45° FOV
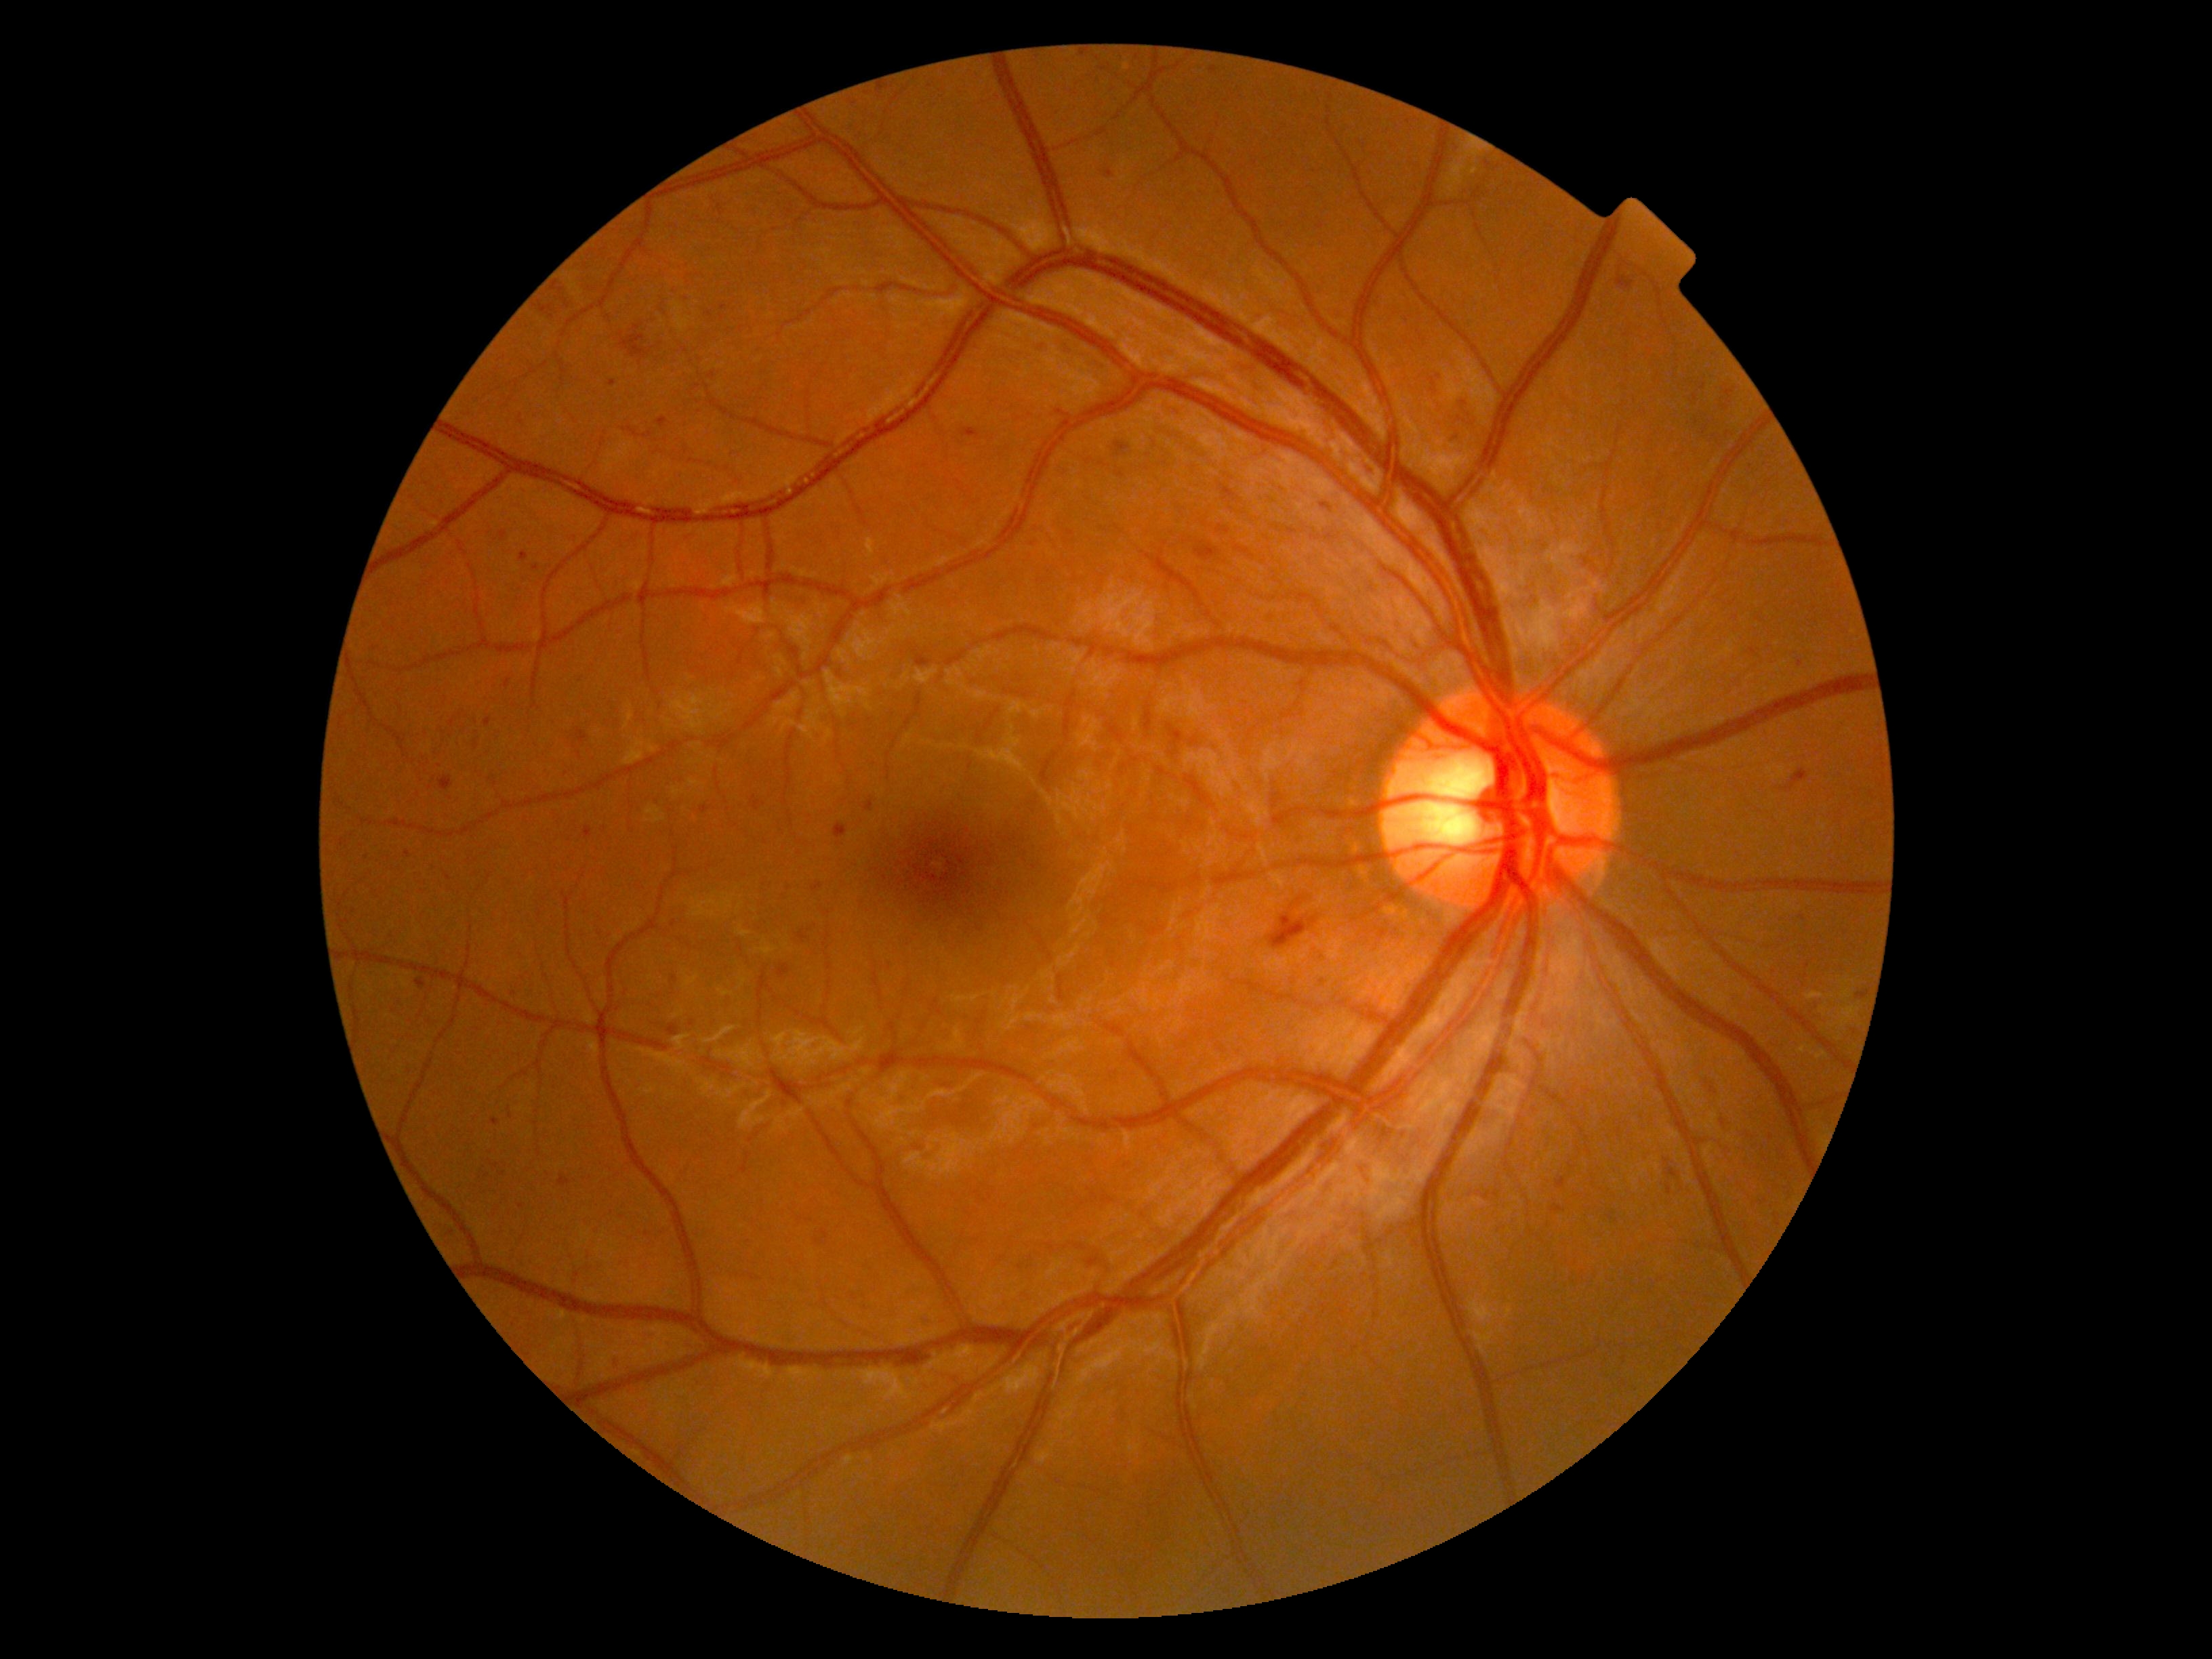 diabetic retinopathy (DR) = grade 2
DR class = non-proliferative diabetic retinopathy